Color fundus image
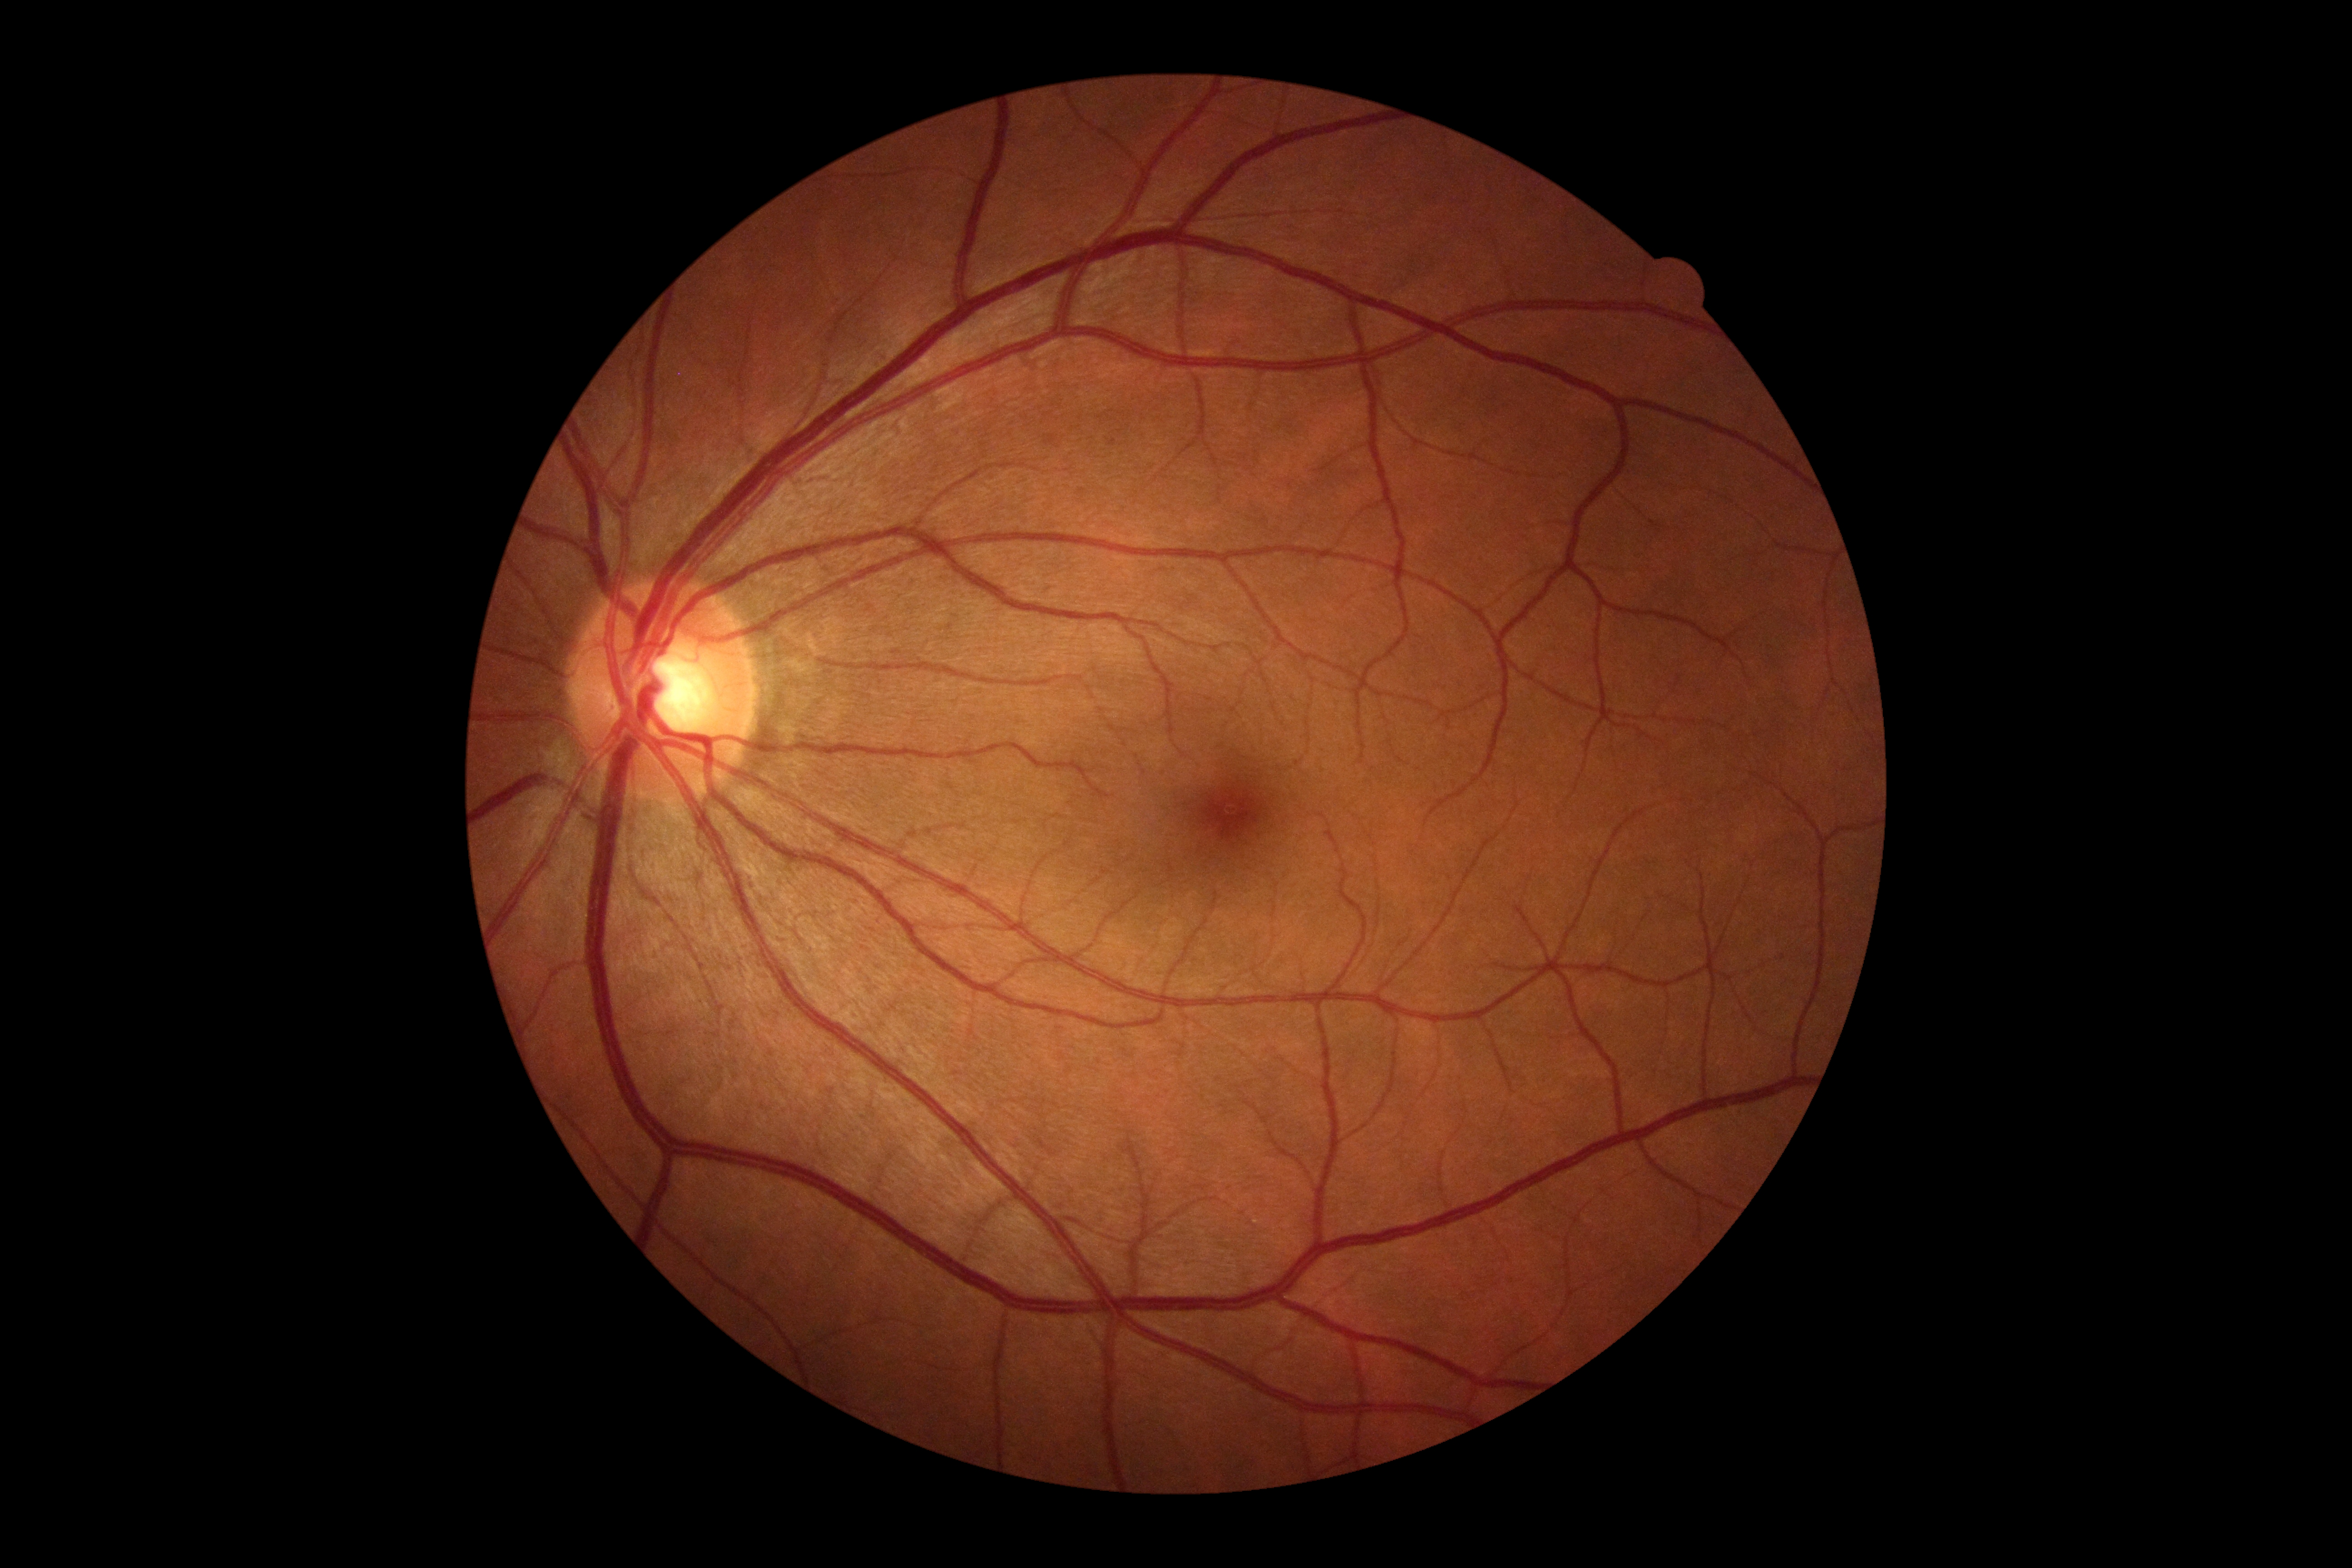

Annotations:
- DR impression — no apparent DR
- DR grade — 0